Color fundus image:
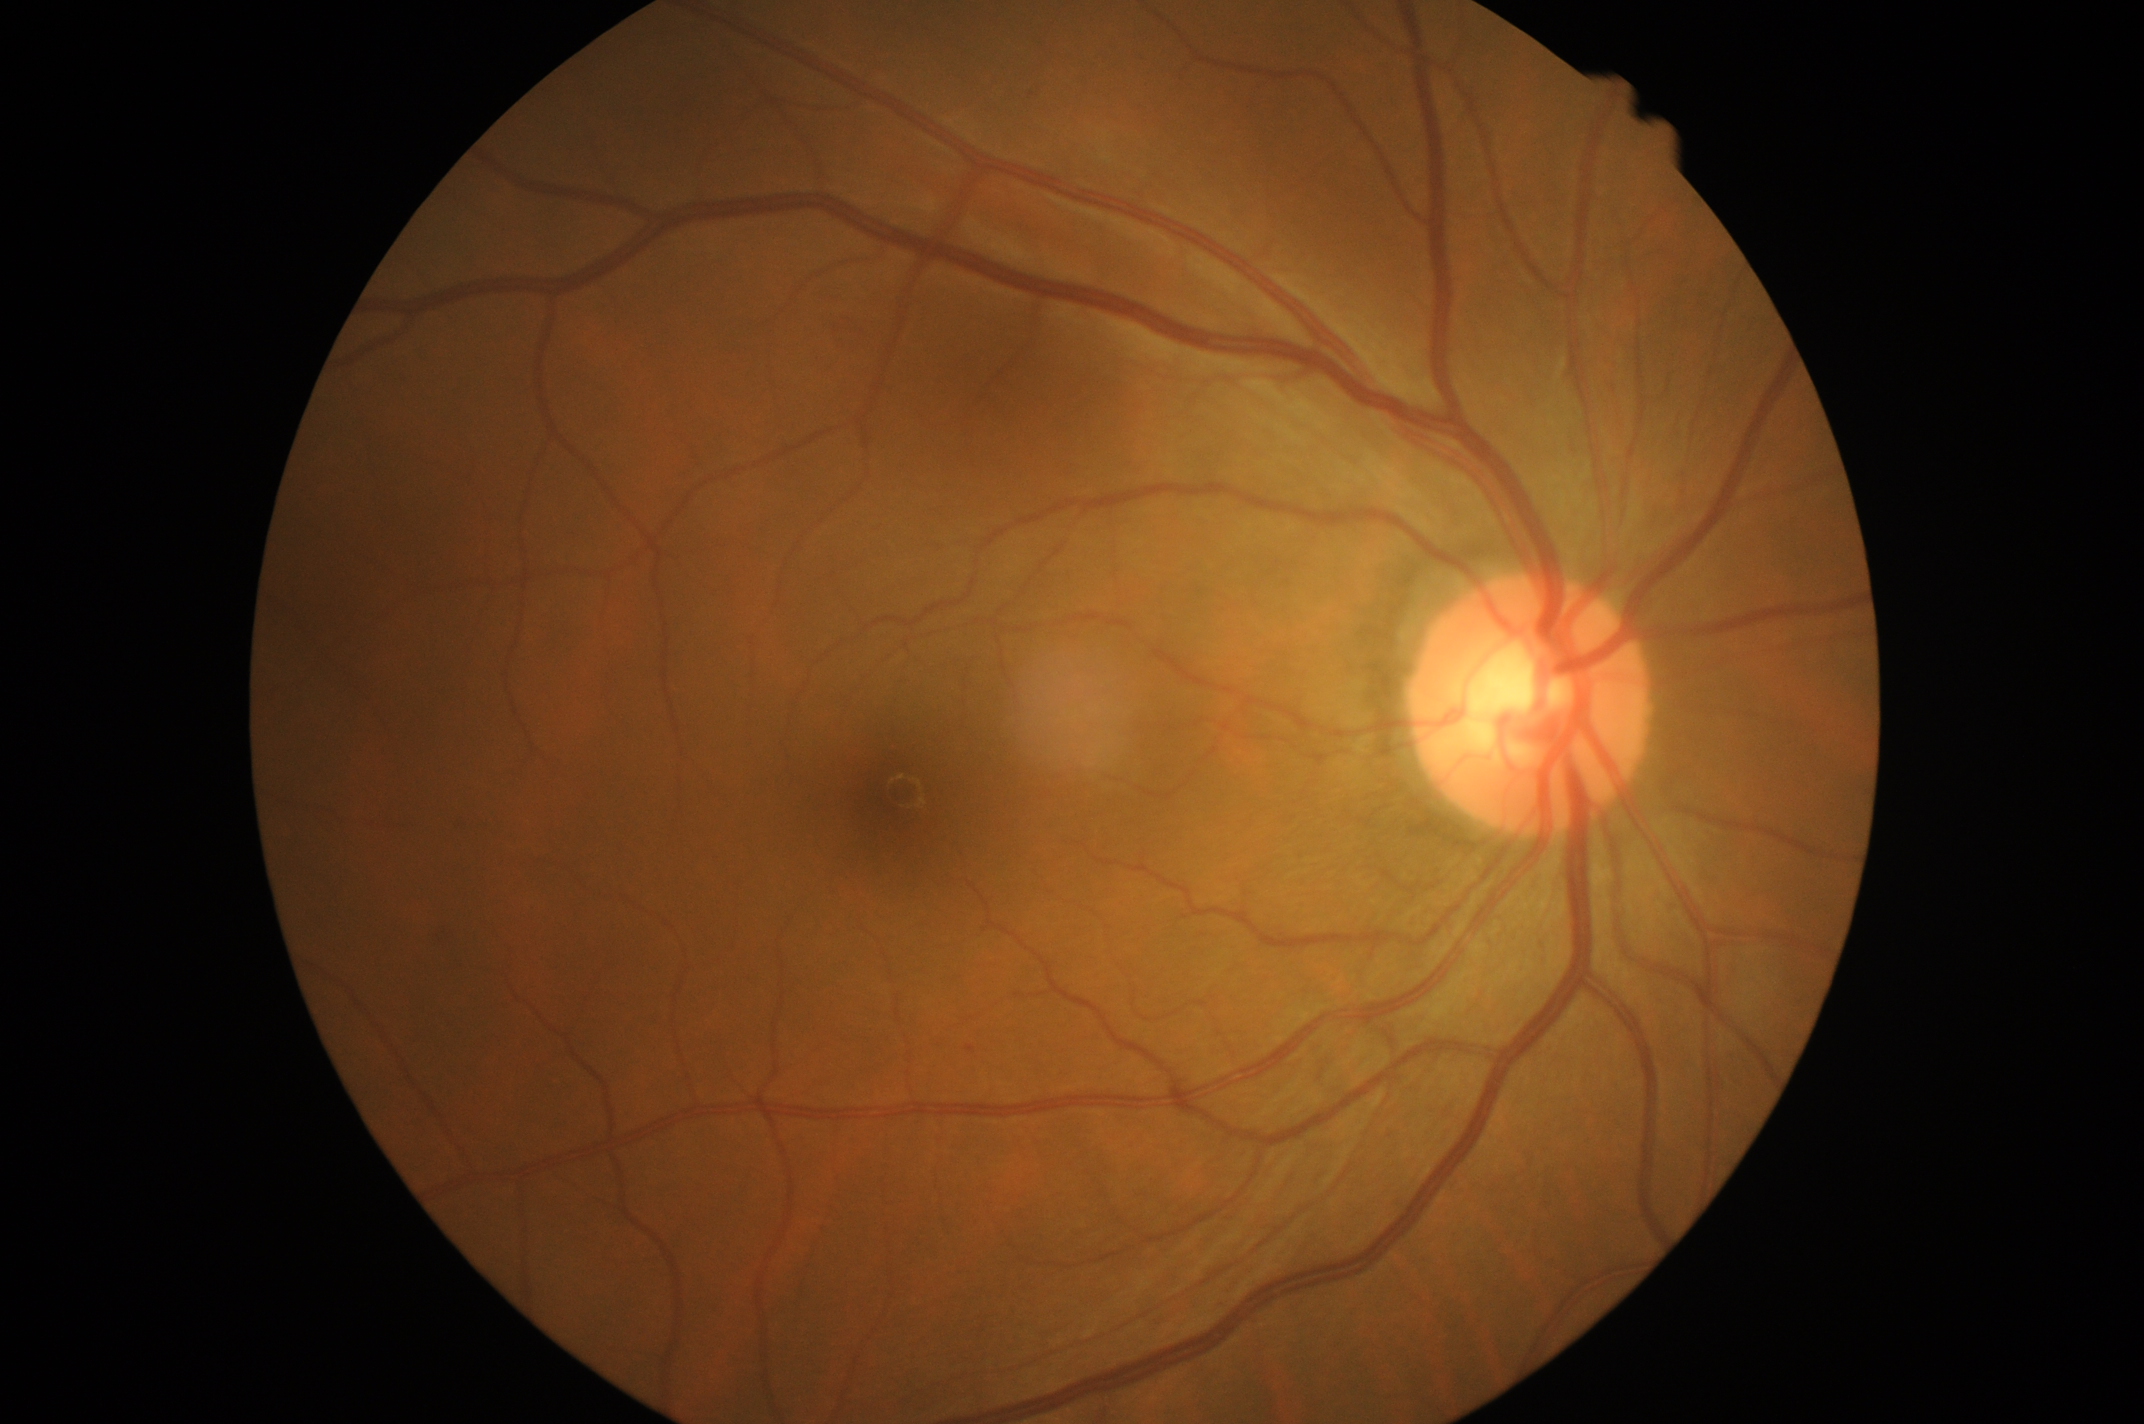 DR is grade 1 (mild NPDR).